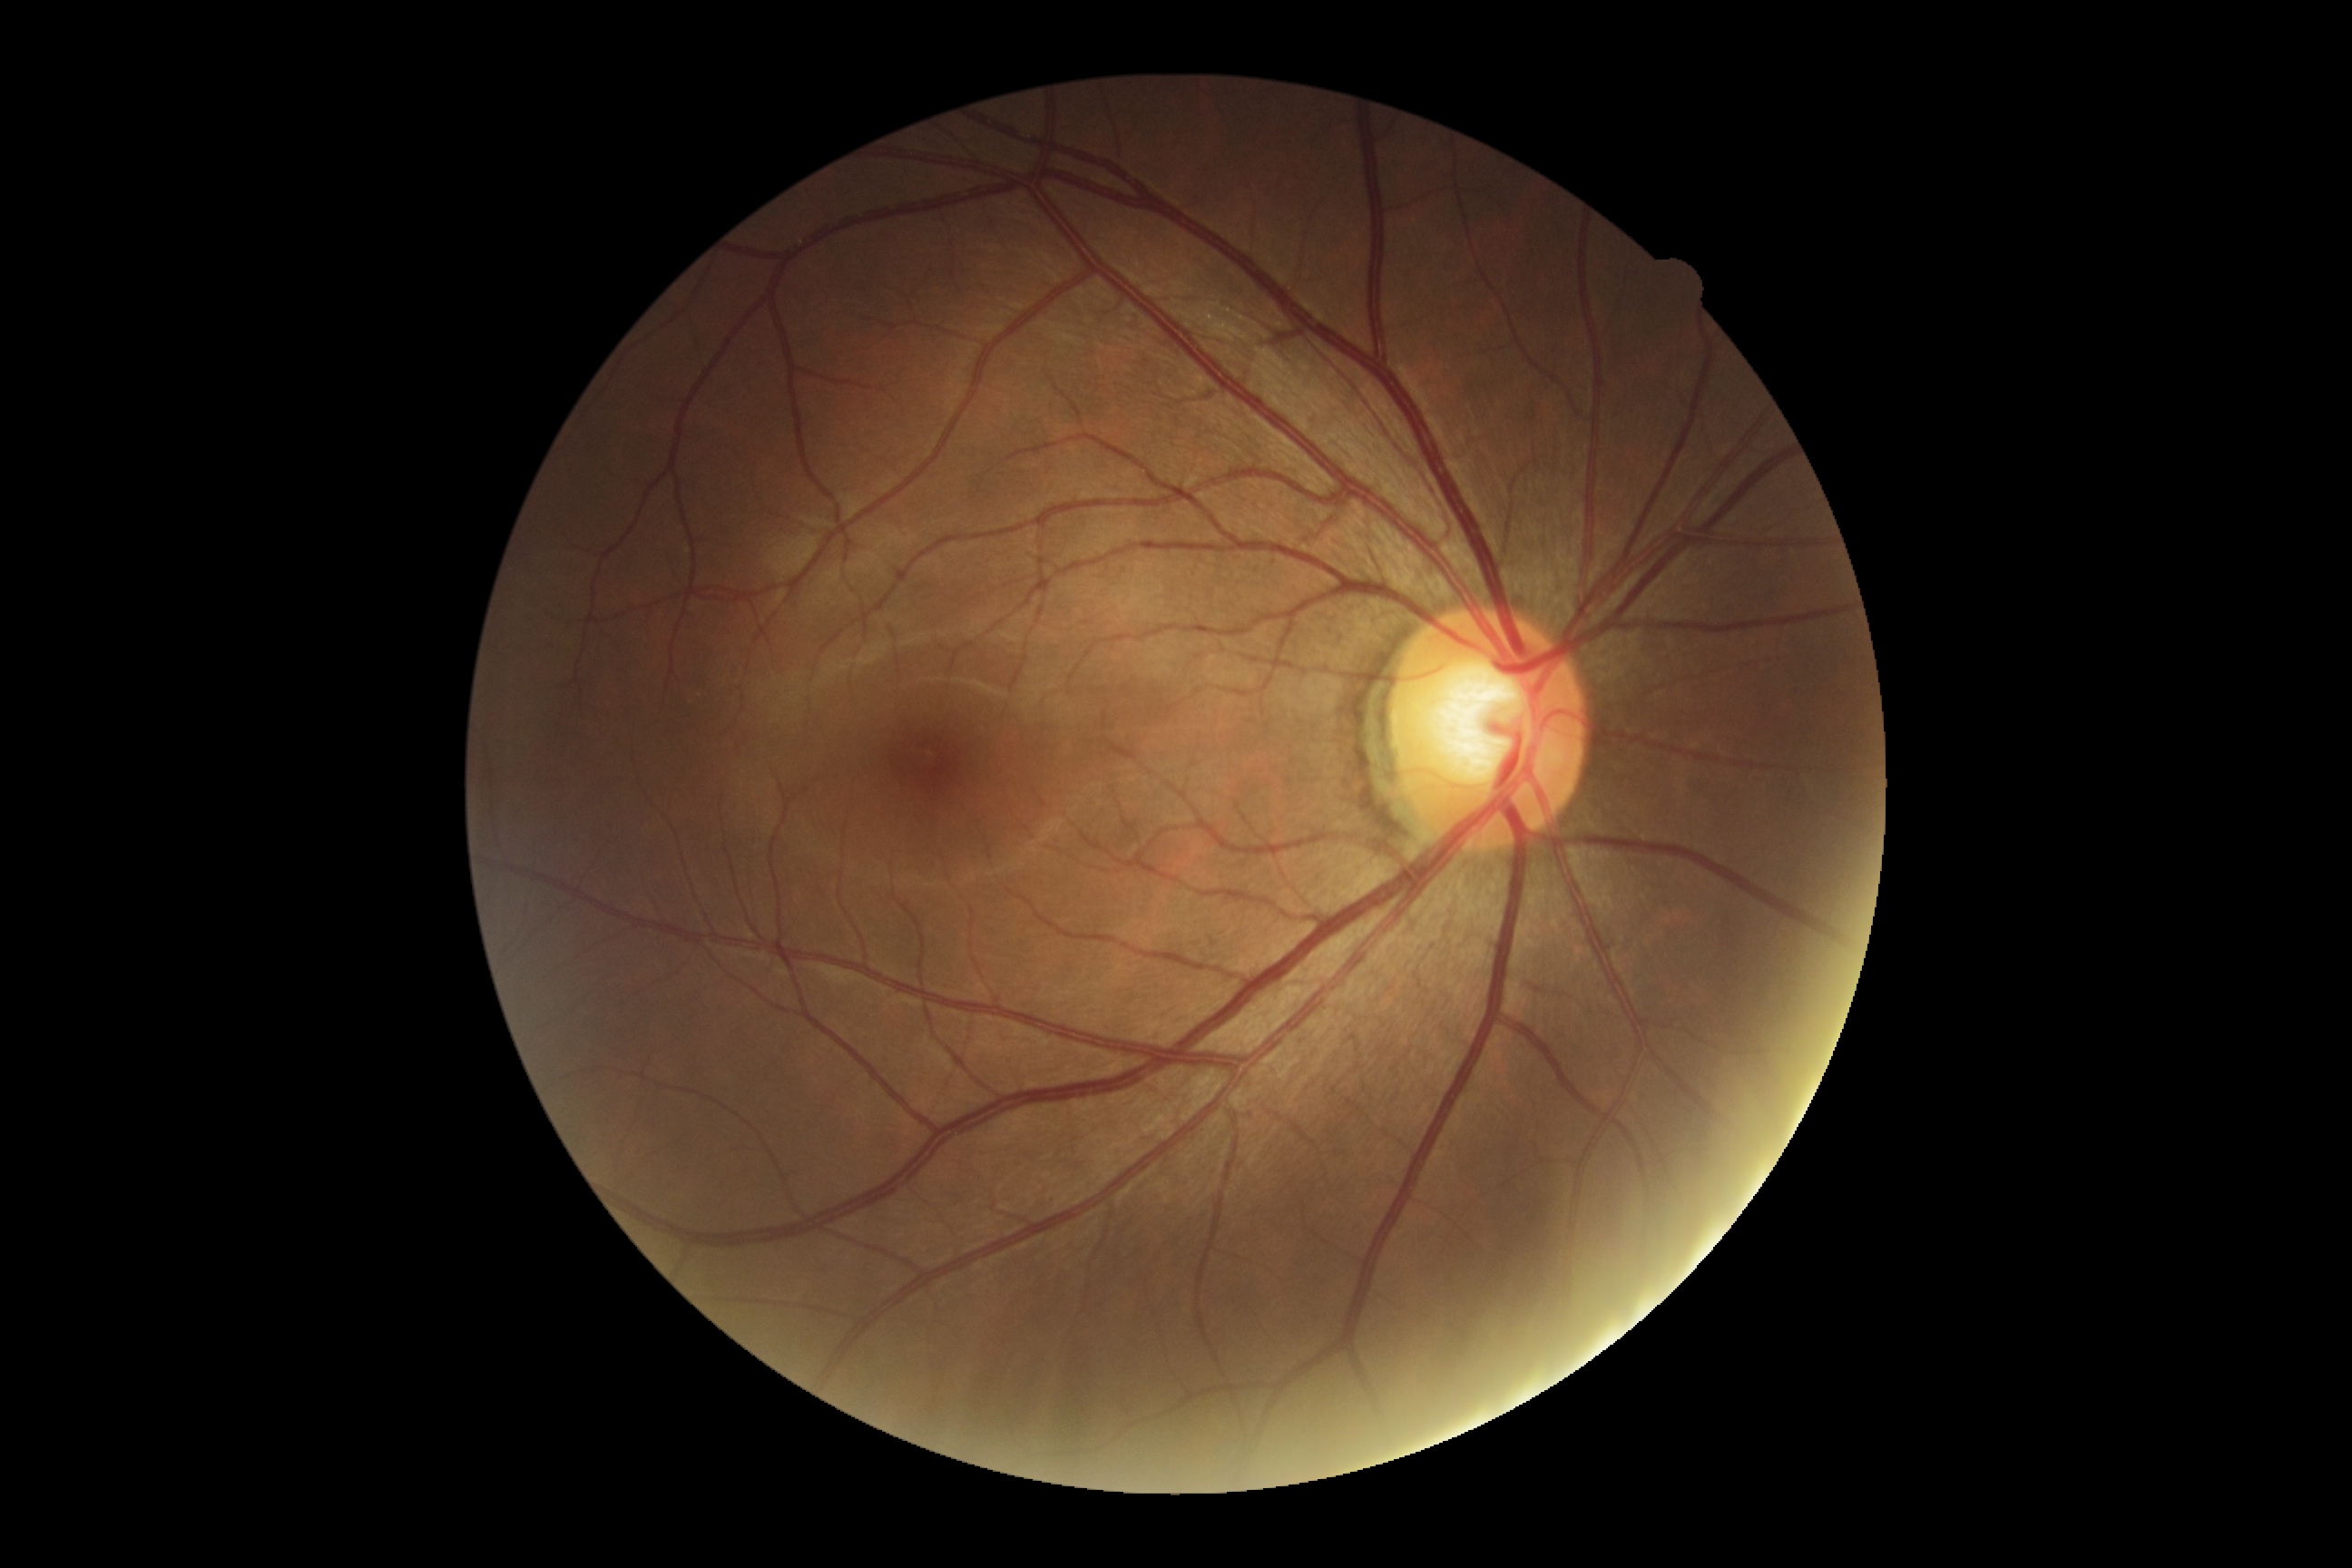

Annotations:
• DR impression: no DR findings
• retinopathy: grade 0 (no apparent retinopathy) — no visible signs of diabetic retinopathy